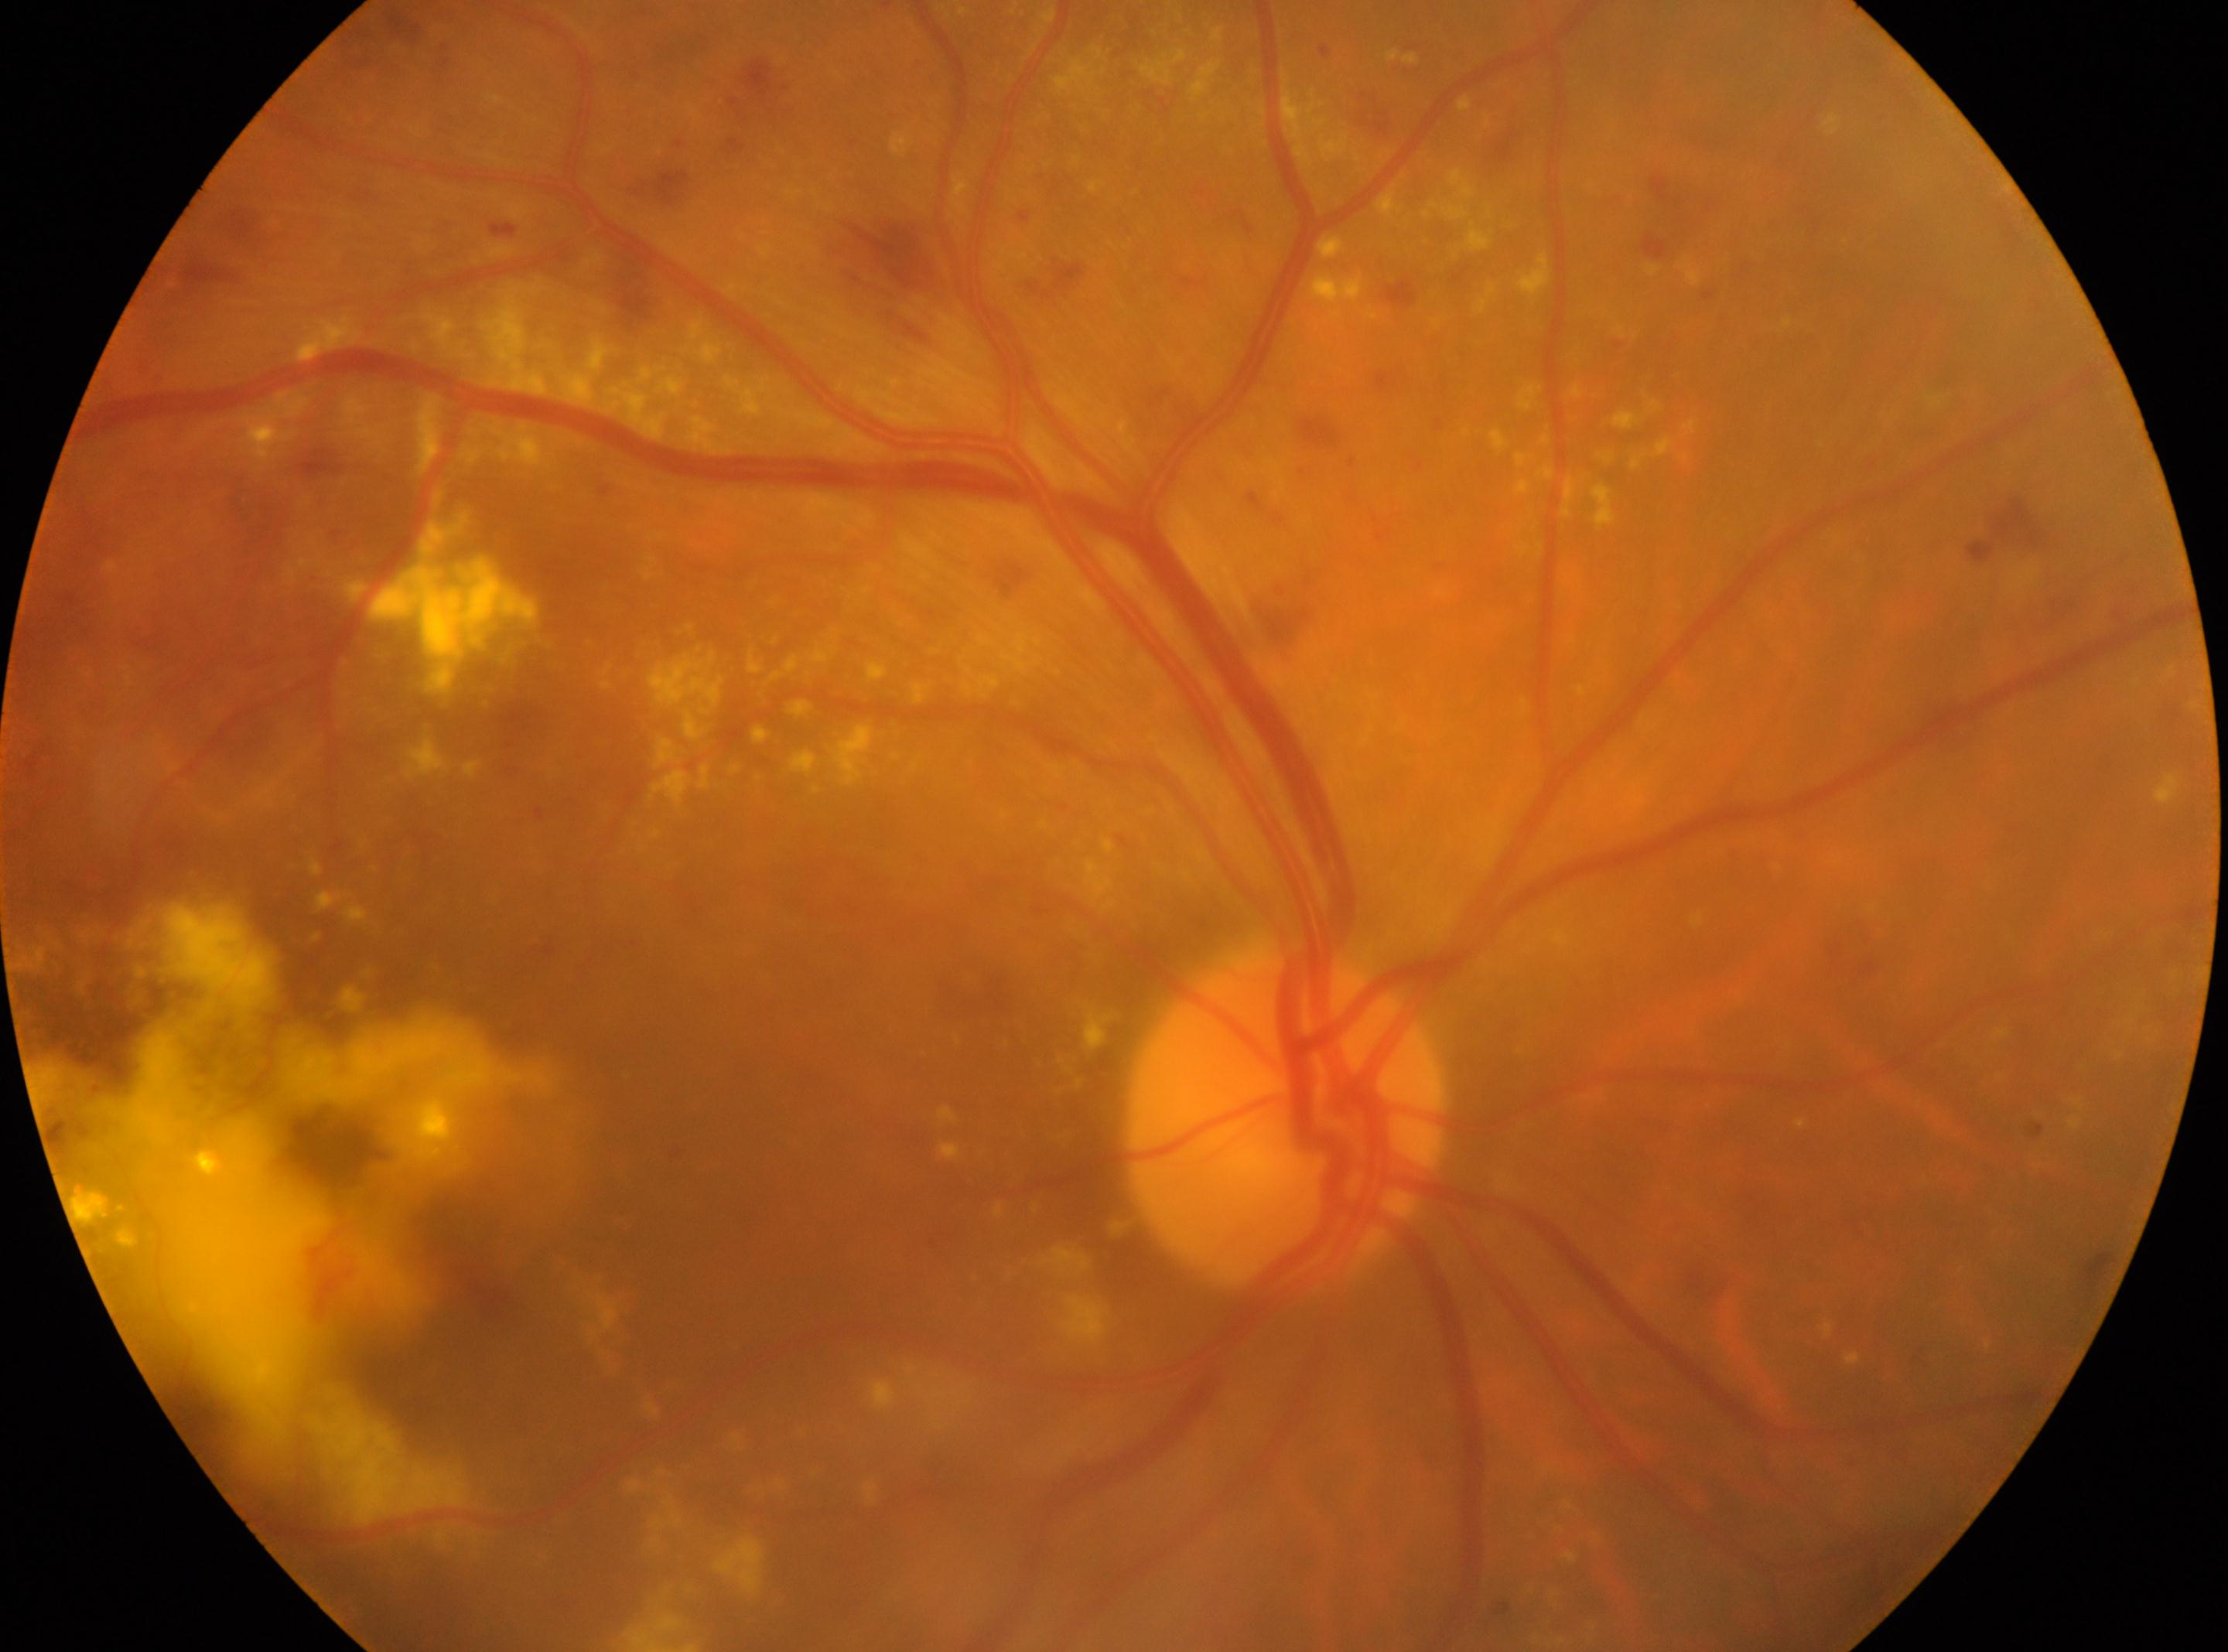 fovea: x=328, y=1188
eye: right eye
dr_grade: 2 (moderate NPDR)
optic_disc: x=1283, y=1126